Image size 2352x1568.
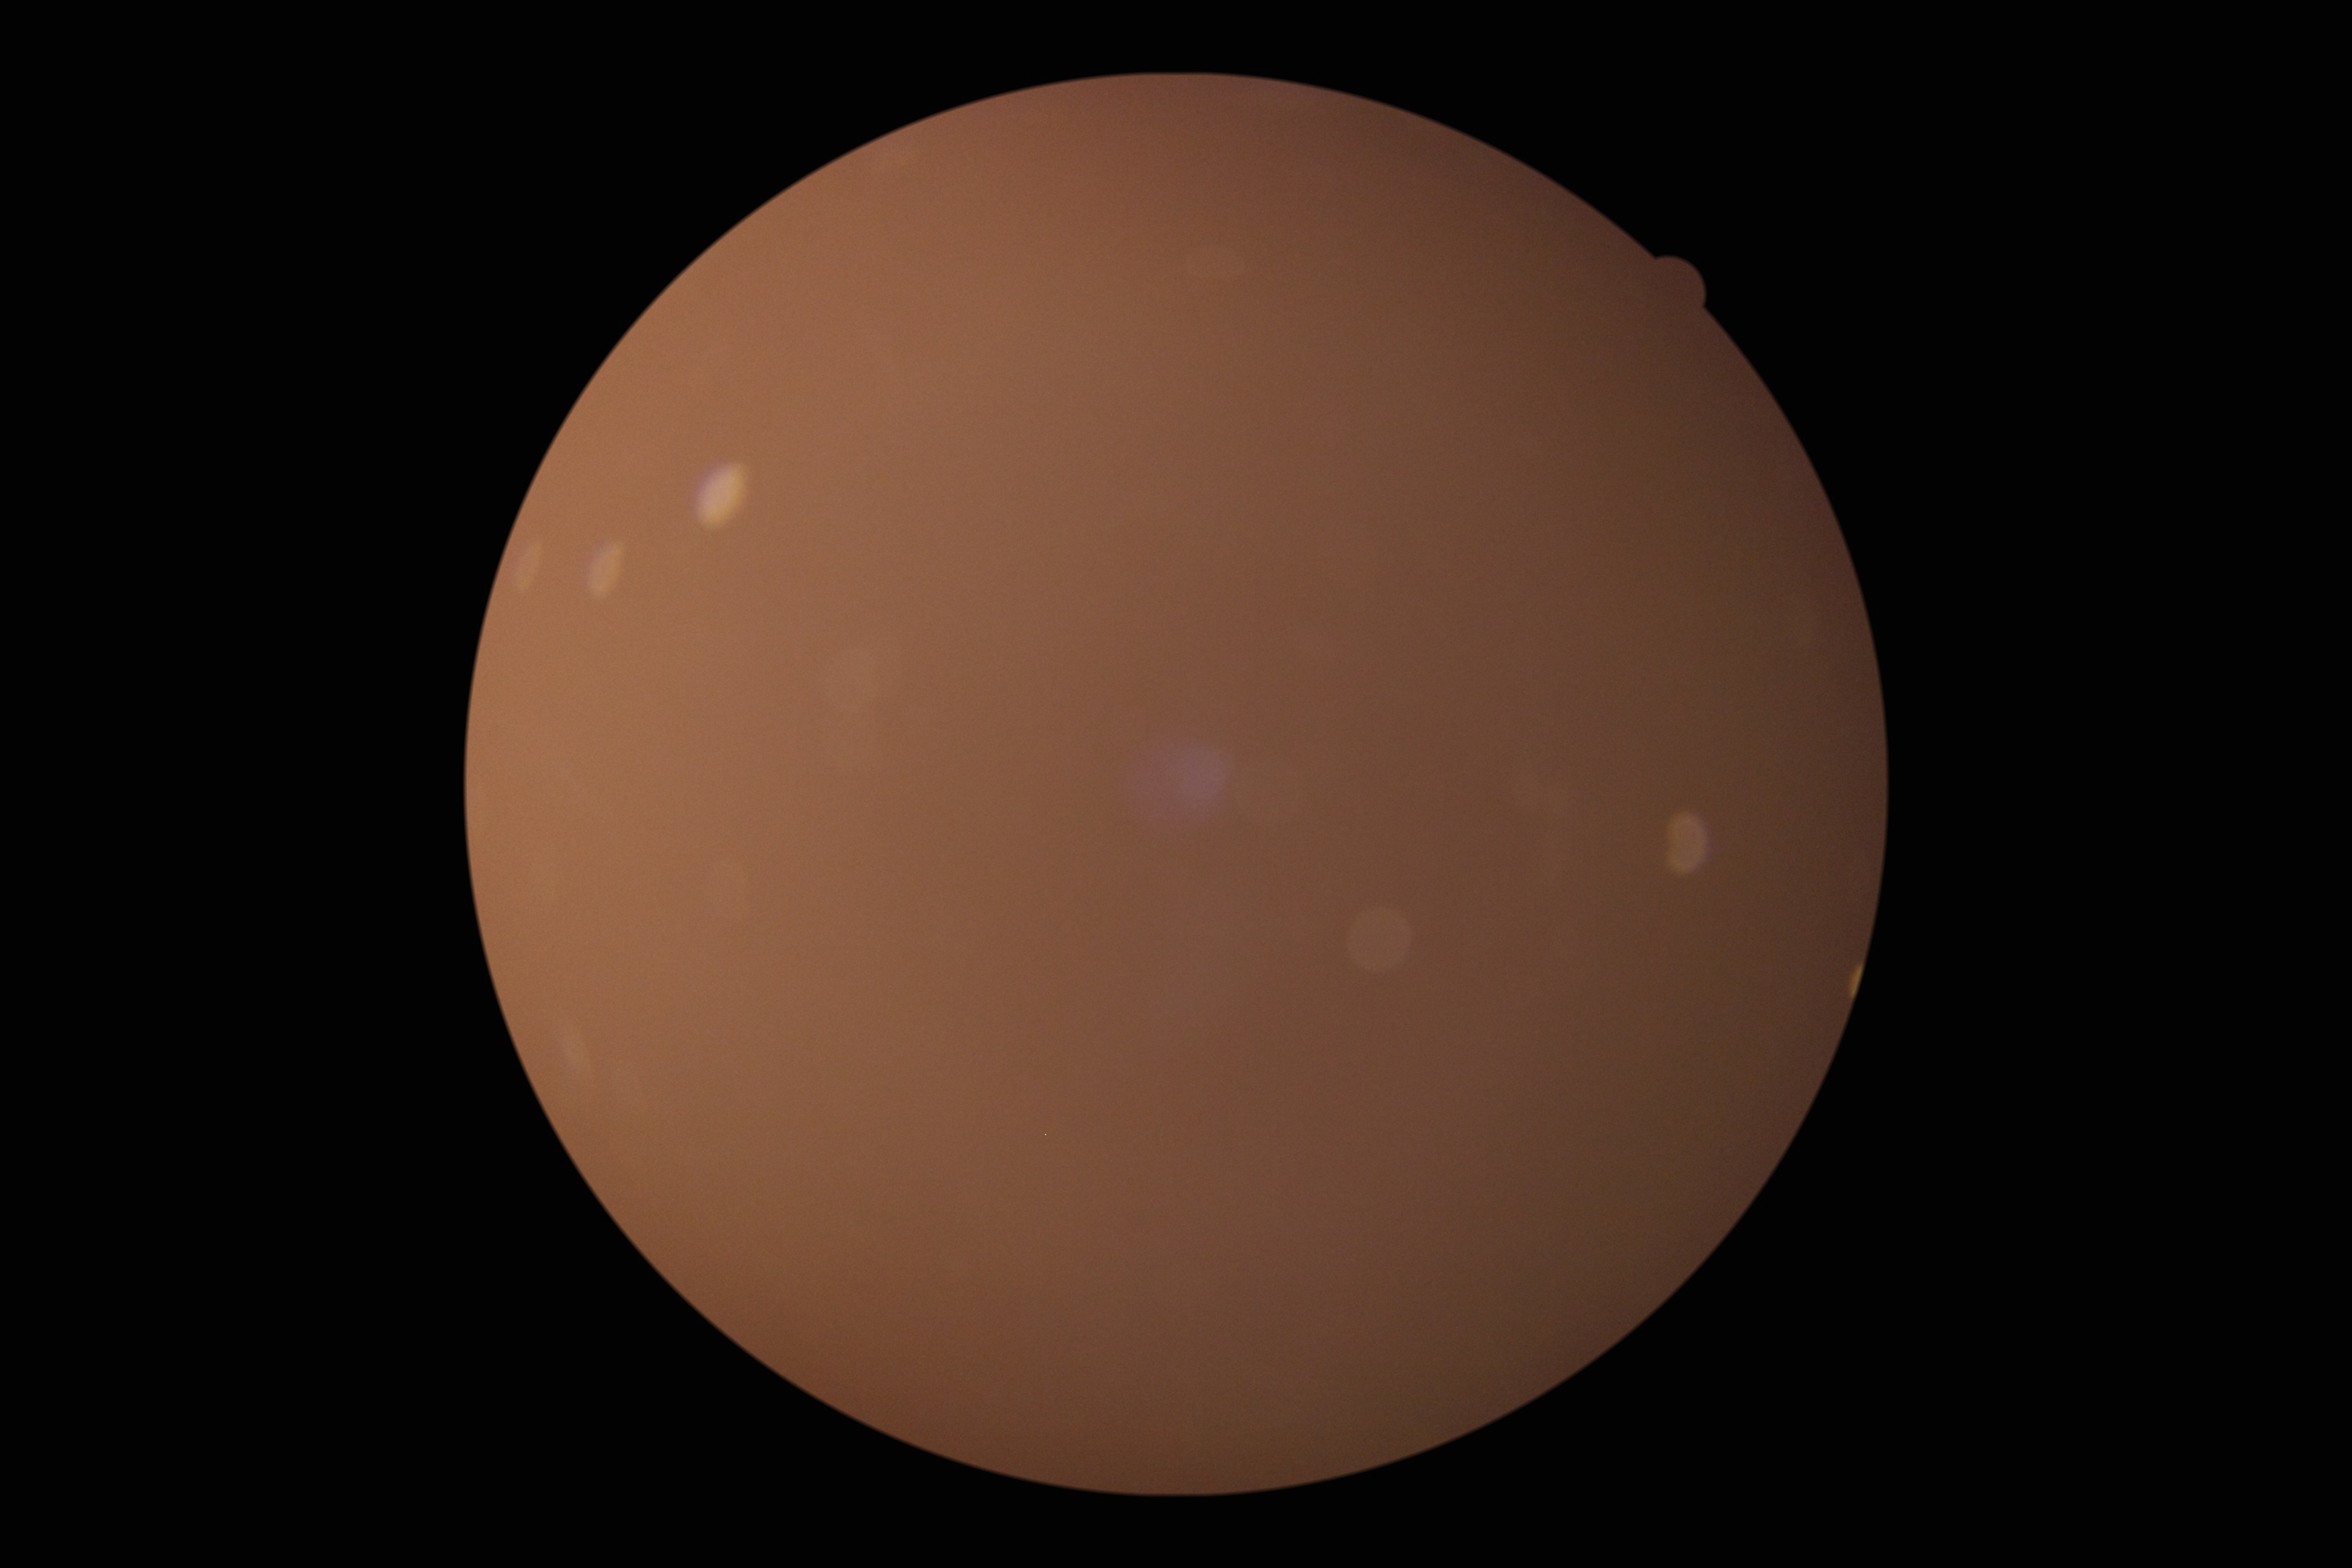

DR severity: ungradable.